2048 x 1536 pixels — 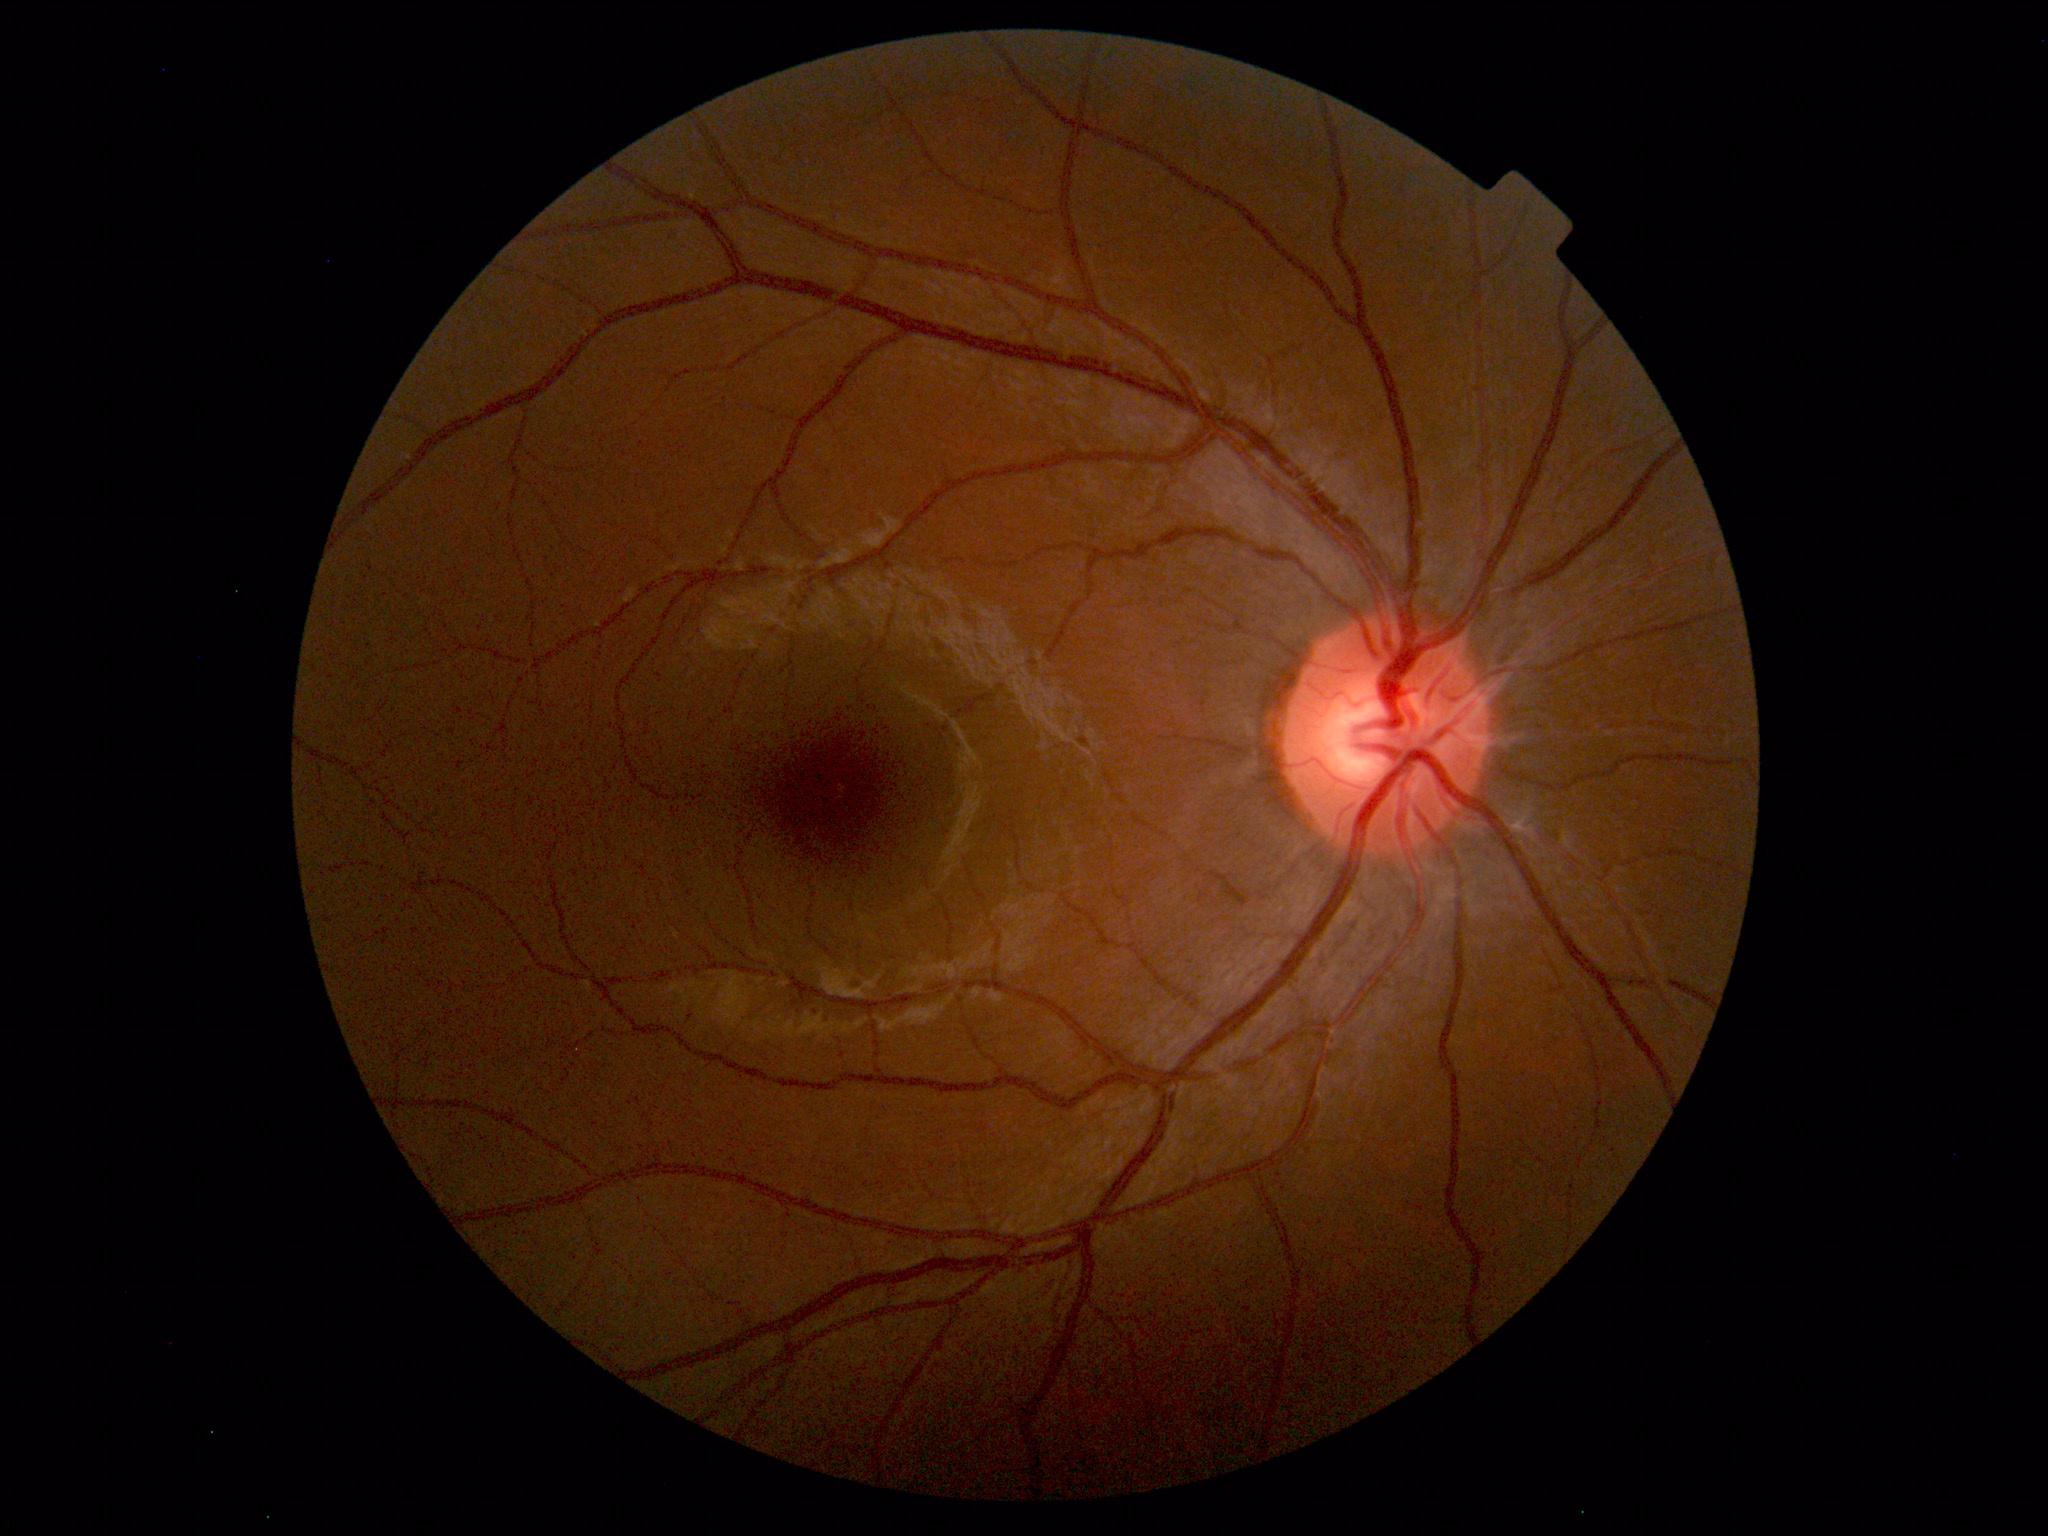

Findings: no abnormalities.